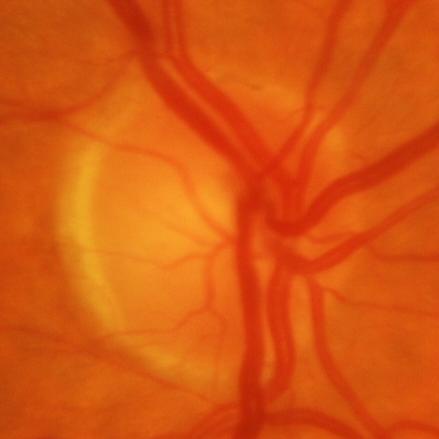 Optic nerve head appearance consistent with glaucomatous optic neuropathy.